Camera: Phoenix ICON (100° FOV); 1240 x 1240 pixels; wide-field fundus photograph of an infant:
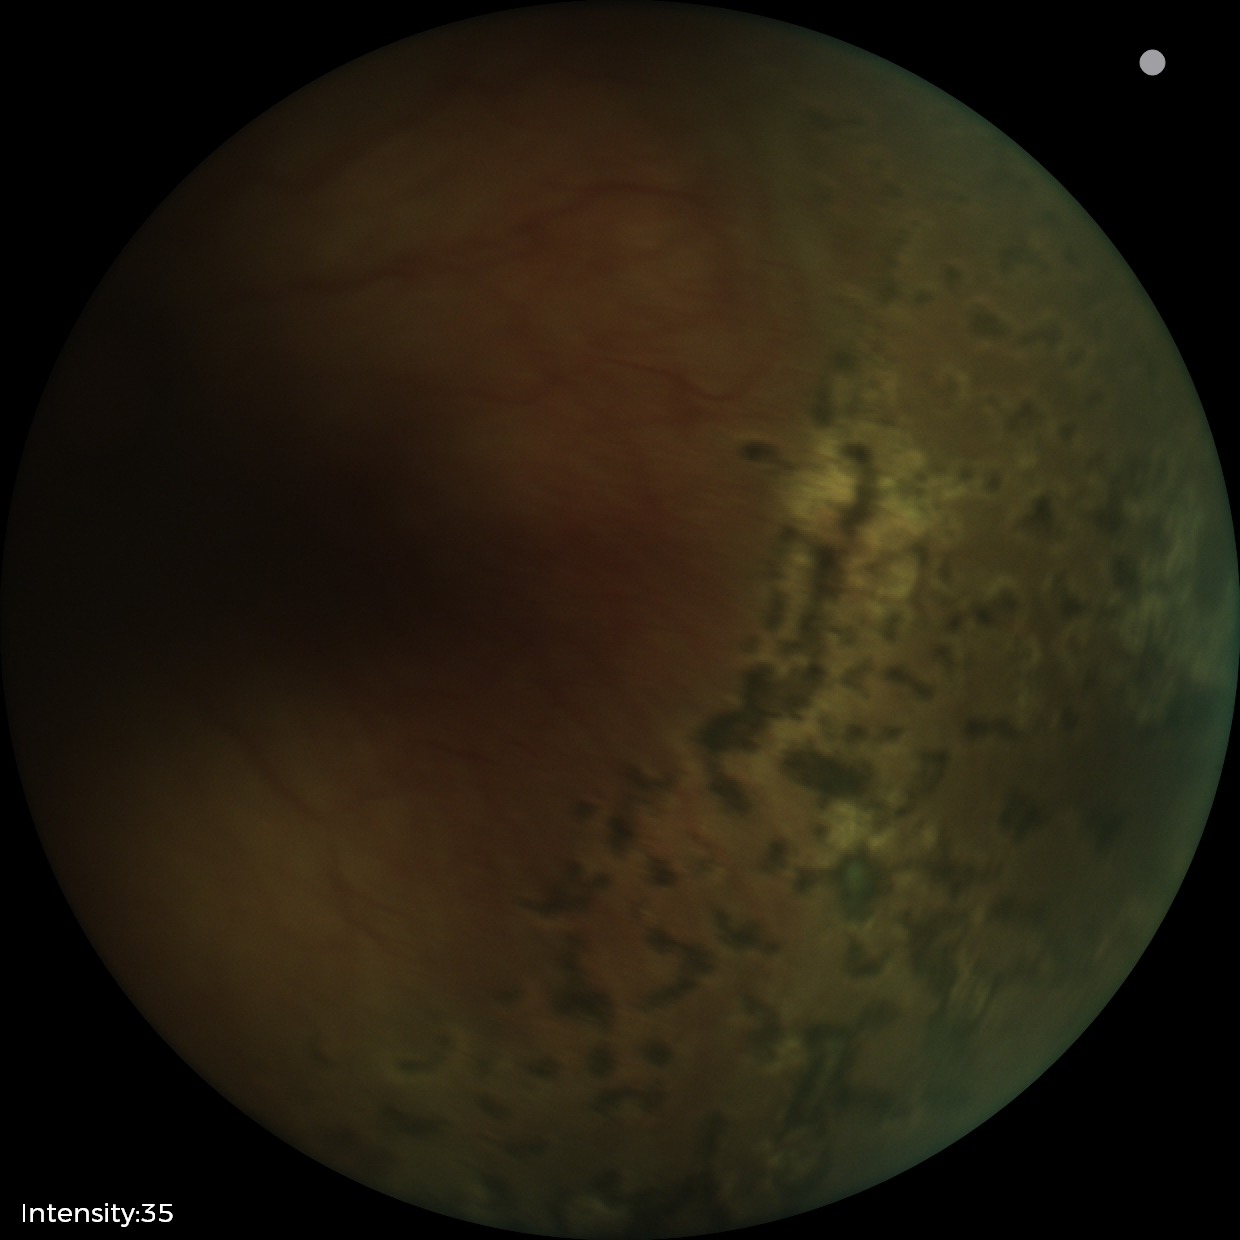 Plus disease: absent | screening diagnosis: status post retinopathy of prematurity (ROP).